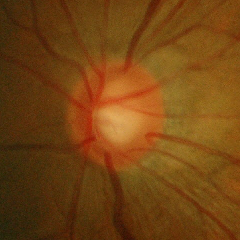

Glaucoma assessment: early-stage glaucoma.